Image size 1440x1080; 130° field of view (Natus RetCam Envision); pediatric retinal photograph (wide-field).
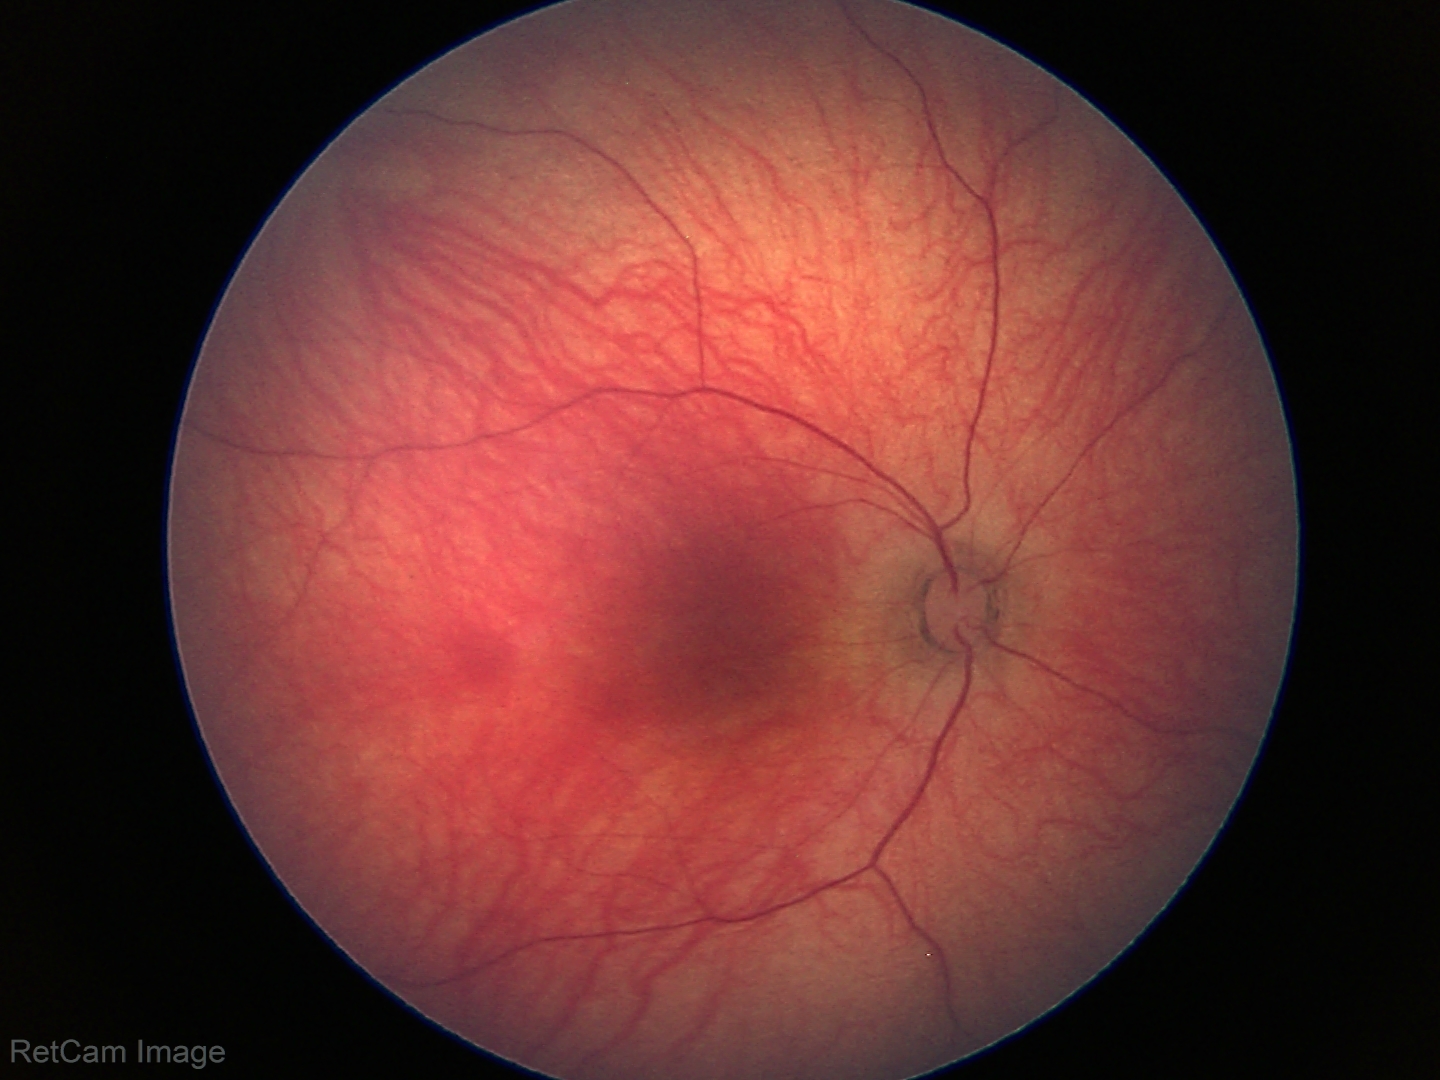
Screening examination diagnosed as physiological.